45-degree field of view: 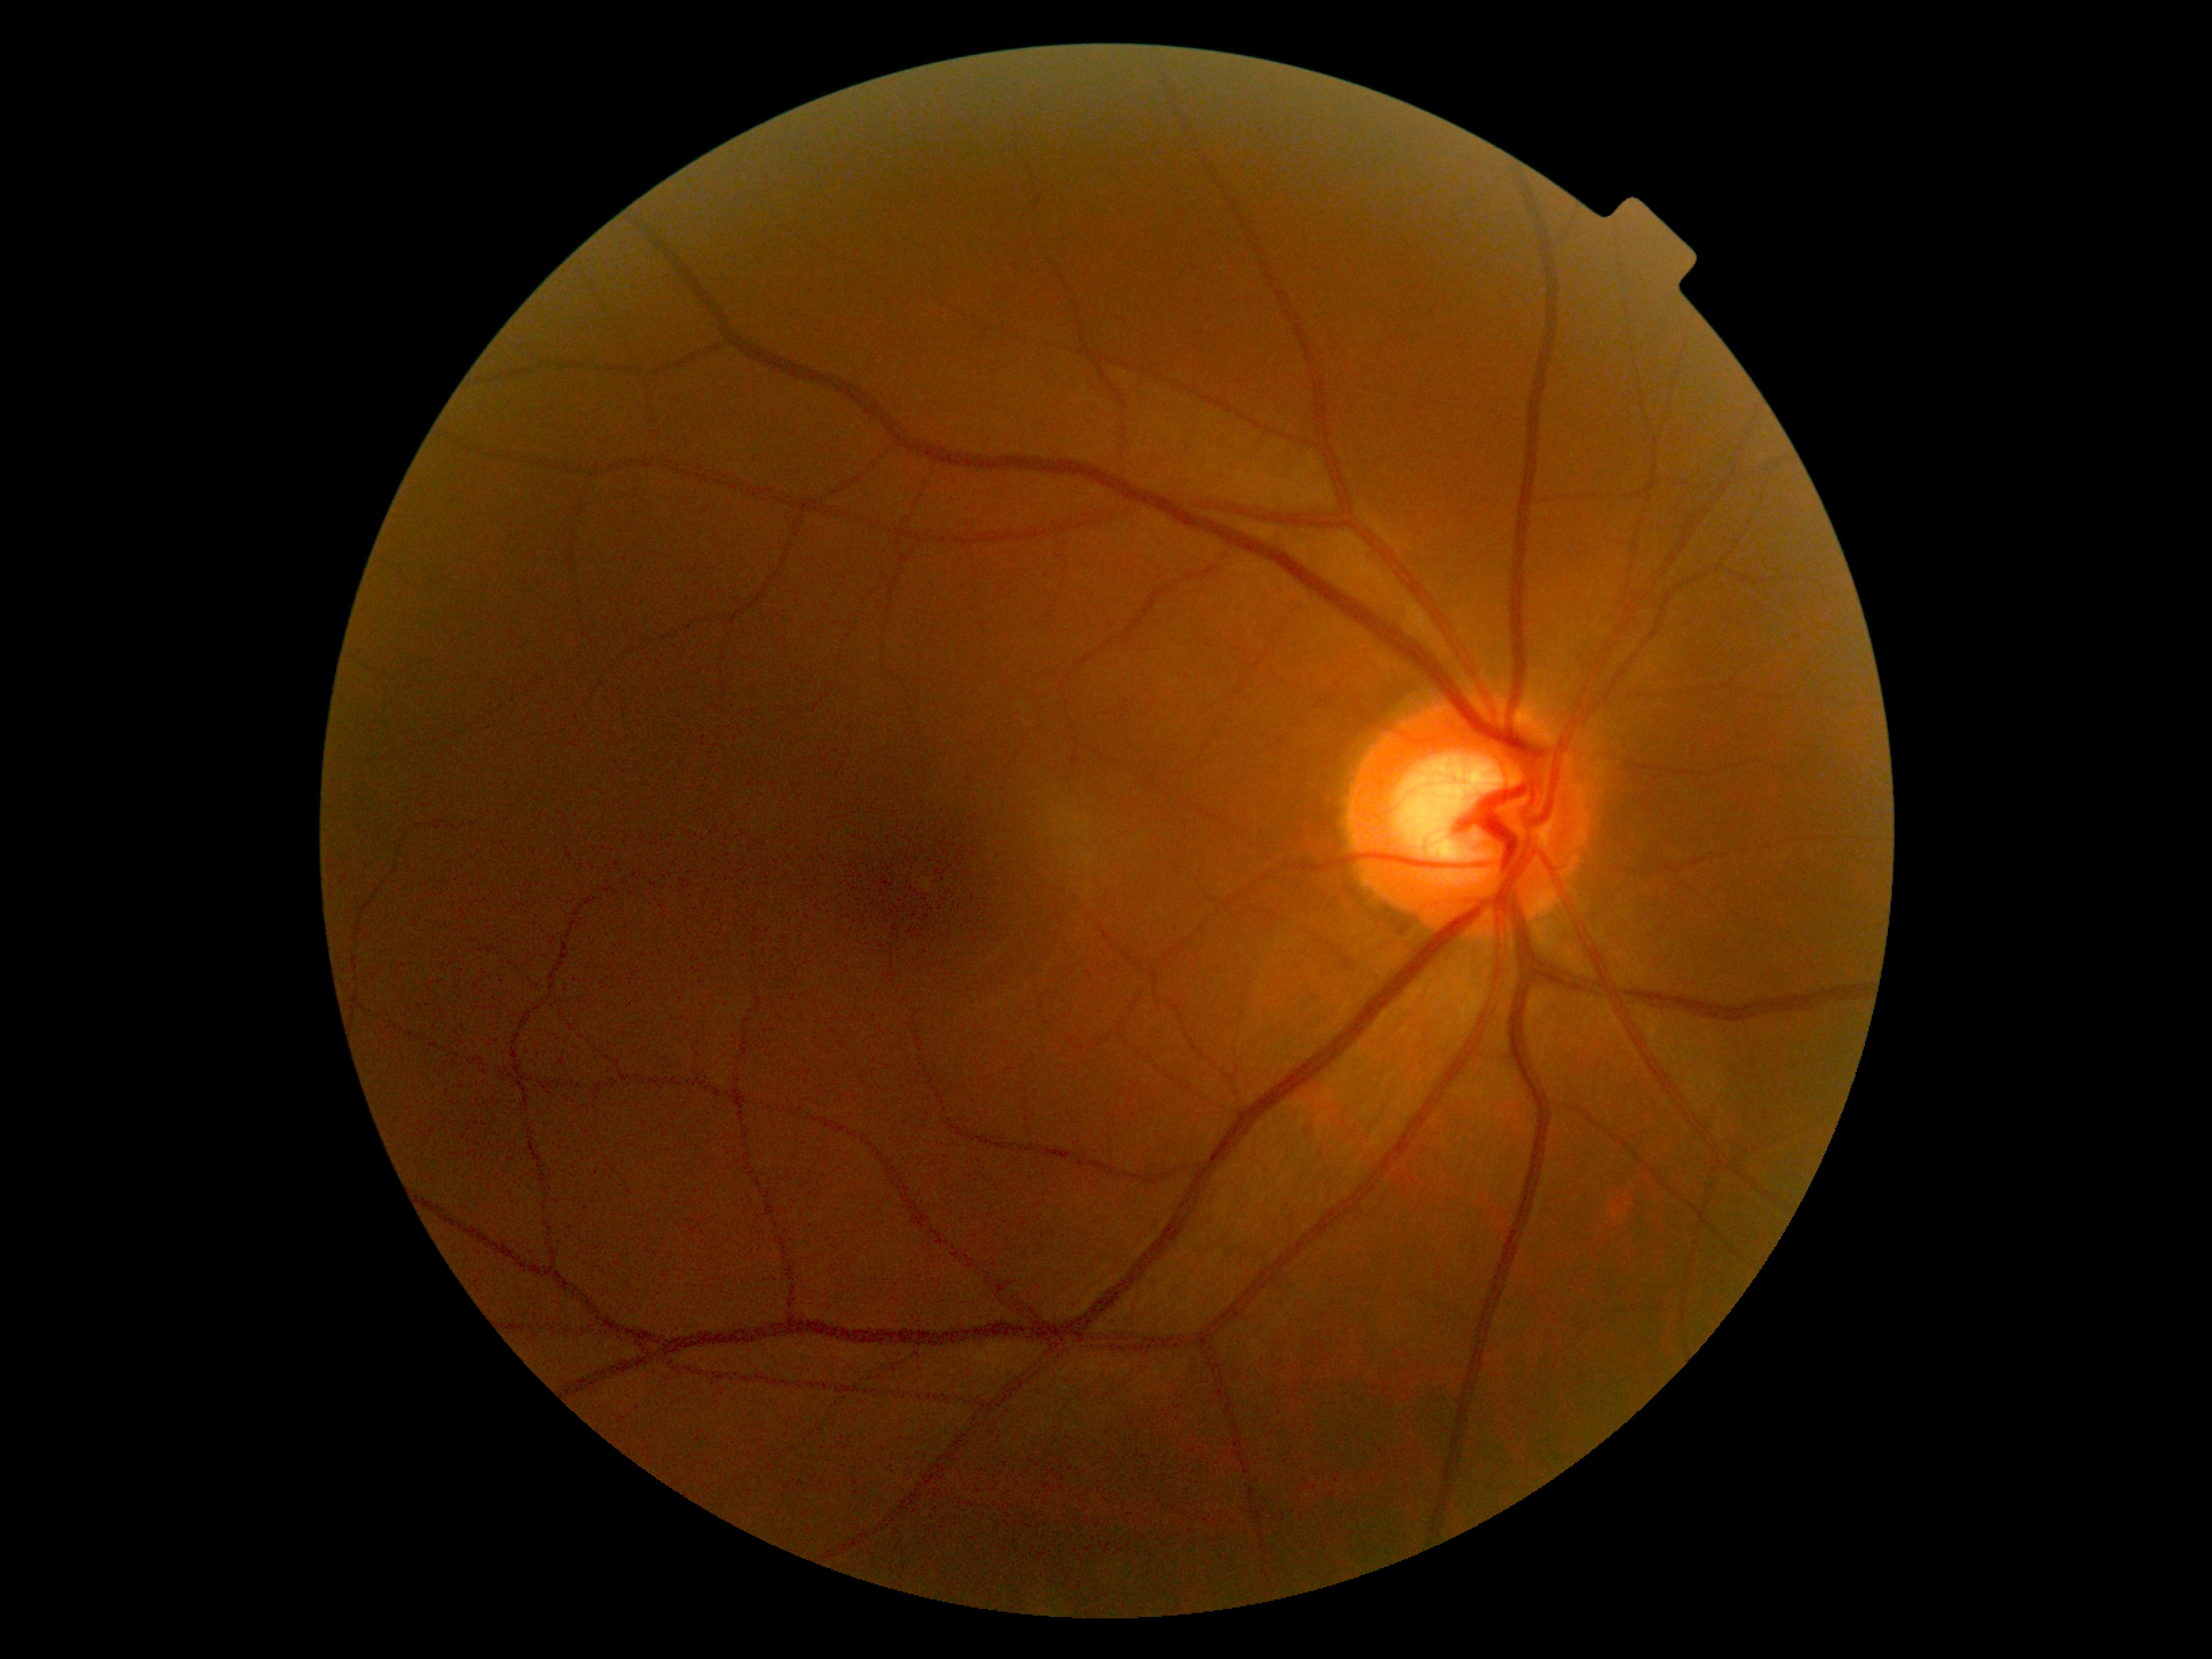 Diabetic retinopathy grade is 0 (no apparent retinopathy). No apparent diabetic retinopathy.